NIDEK AFC-230 fundus camera, FOV: 45 degrees — 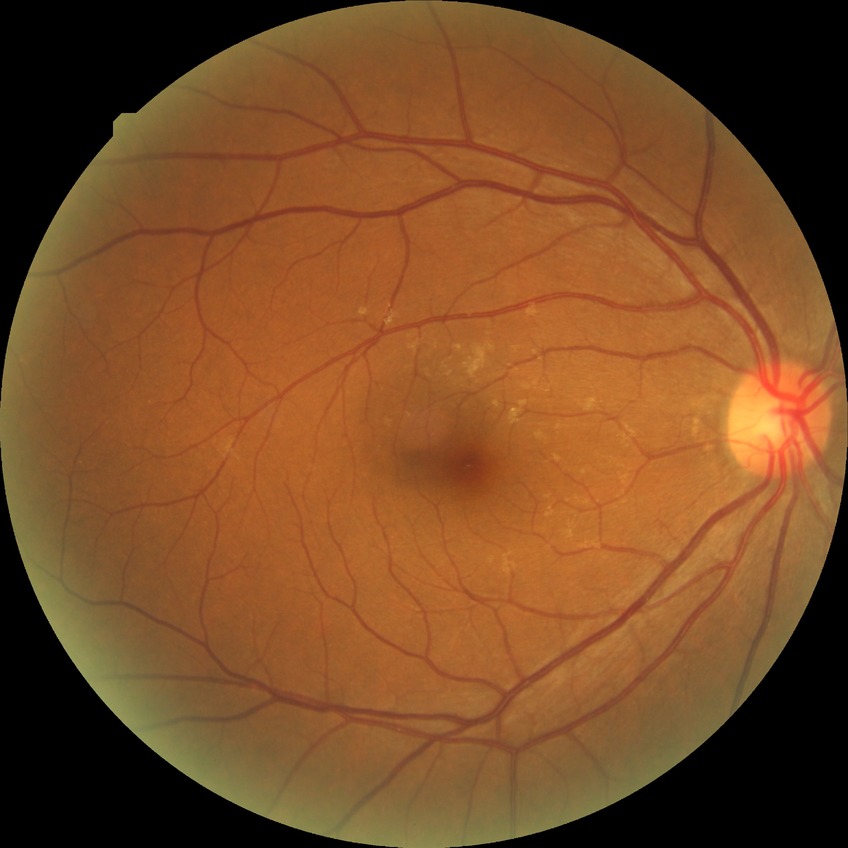

Annotations:
• diabetic retinopathy (DR) — NDR (no diabetic retinopathy)